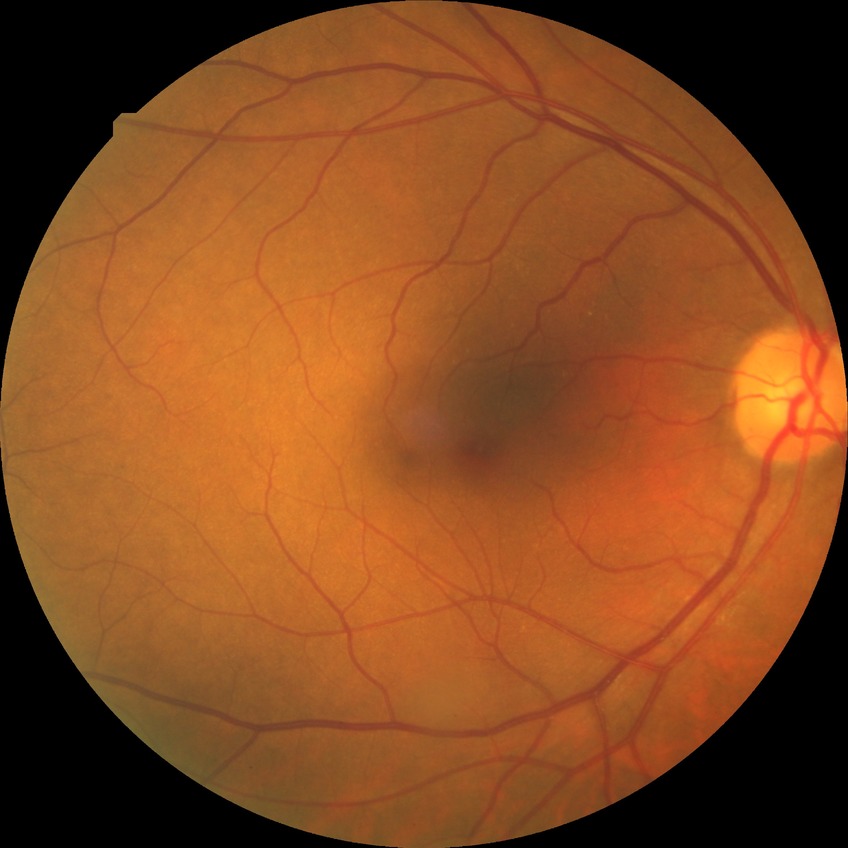

Davis grade: NDR.